Wide-field fundus photograph of an infant; 1240x1240px — 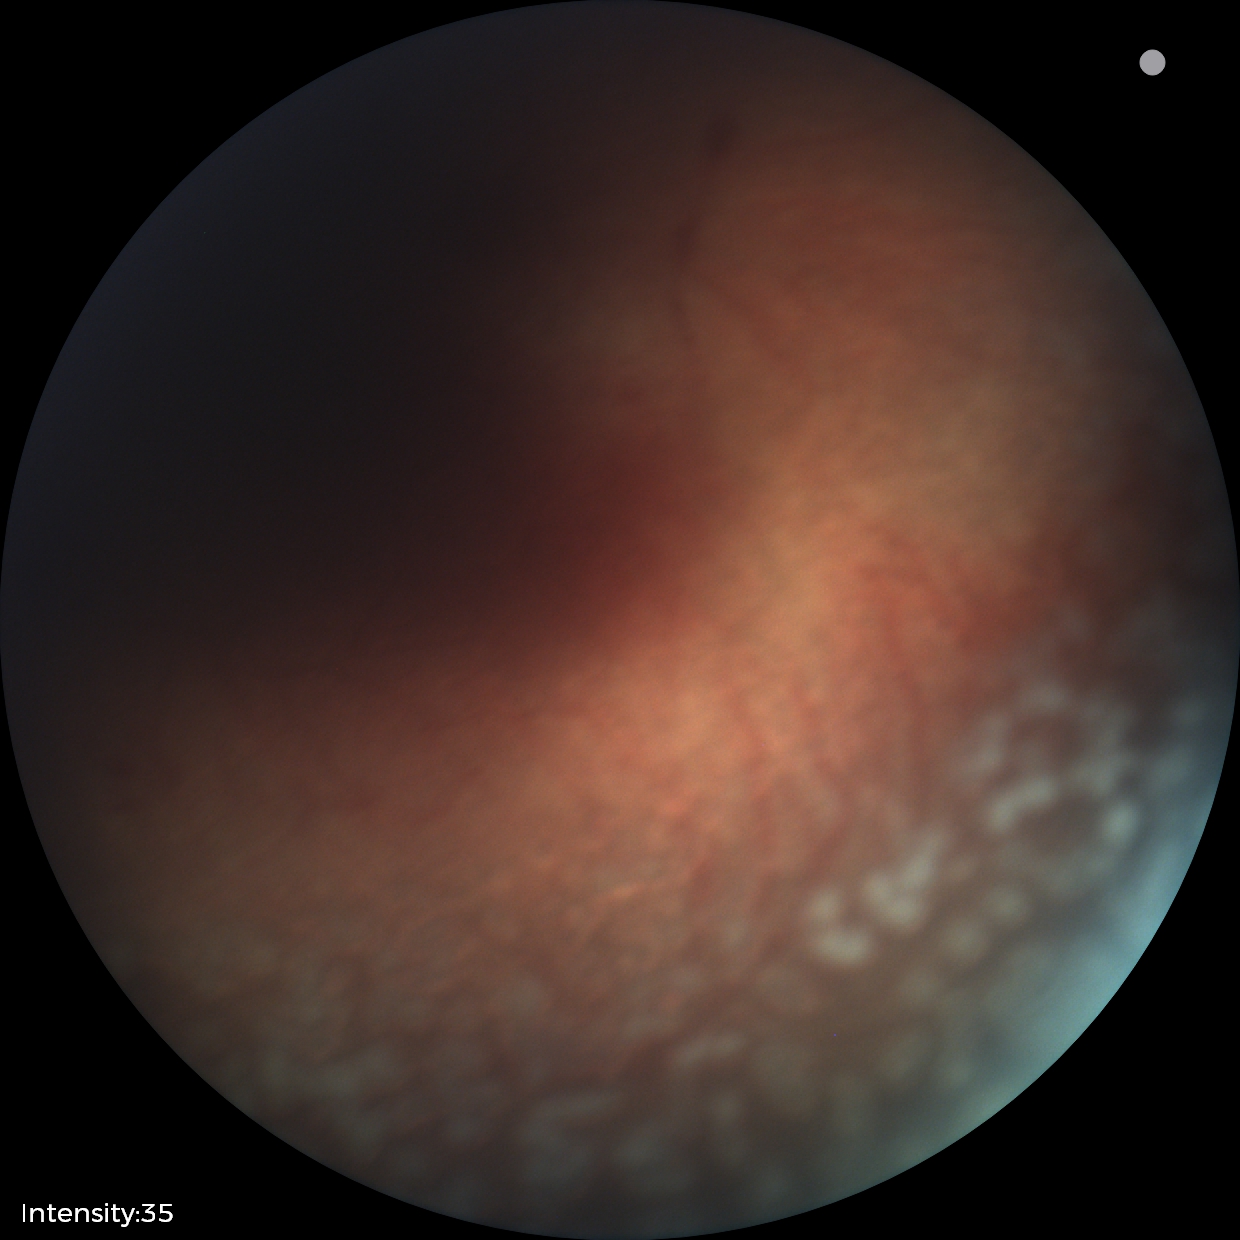

Screening series with ROP stage 2.